Color fundus image. 45° FOV. 2184 by 1690 pixels:
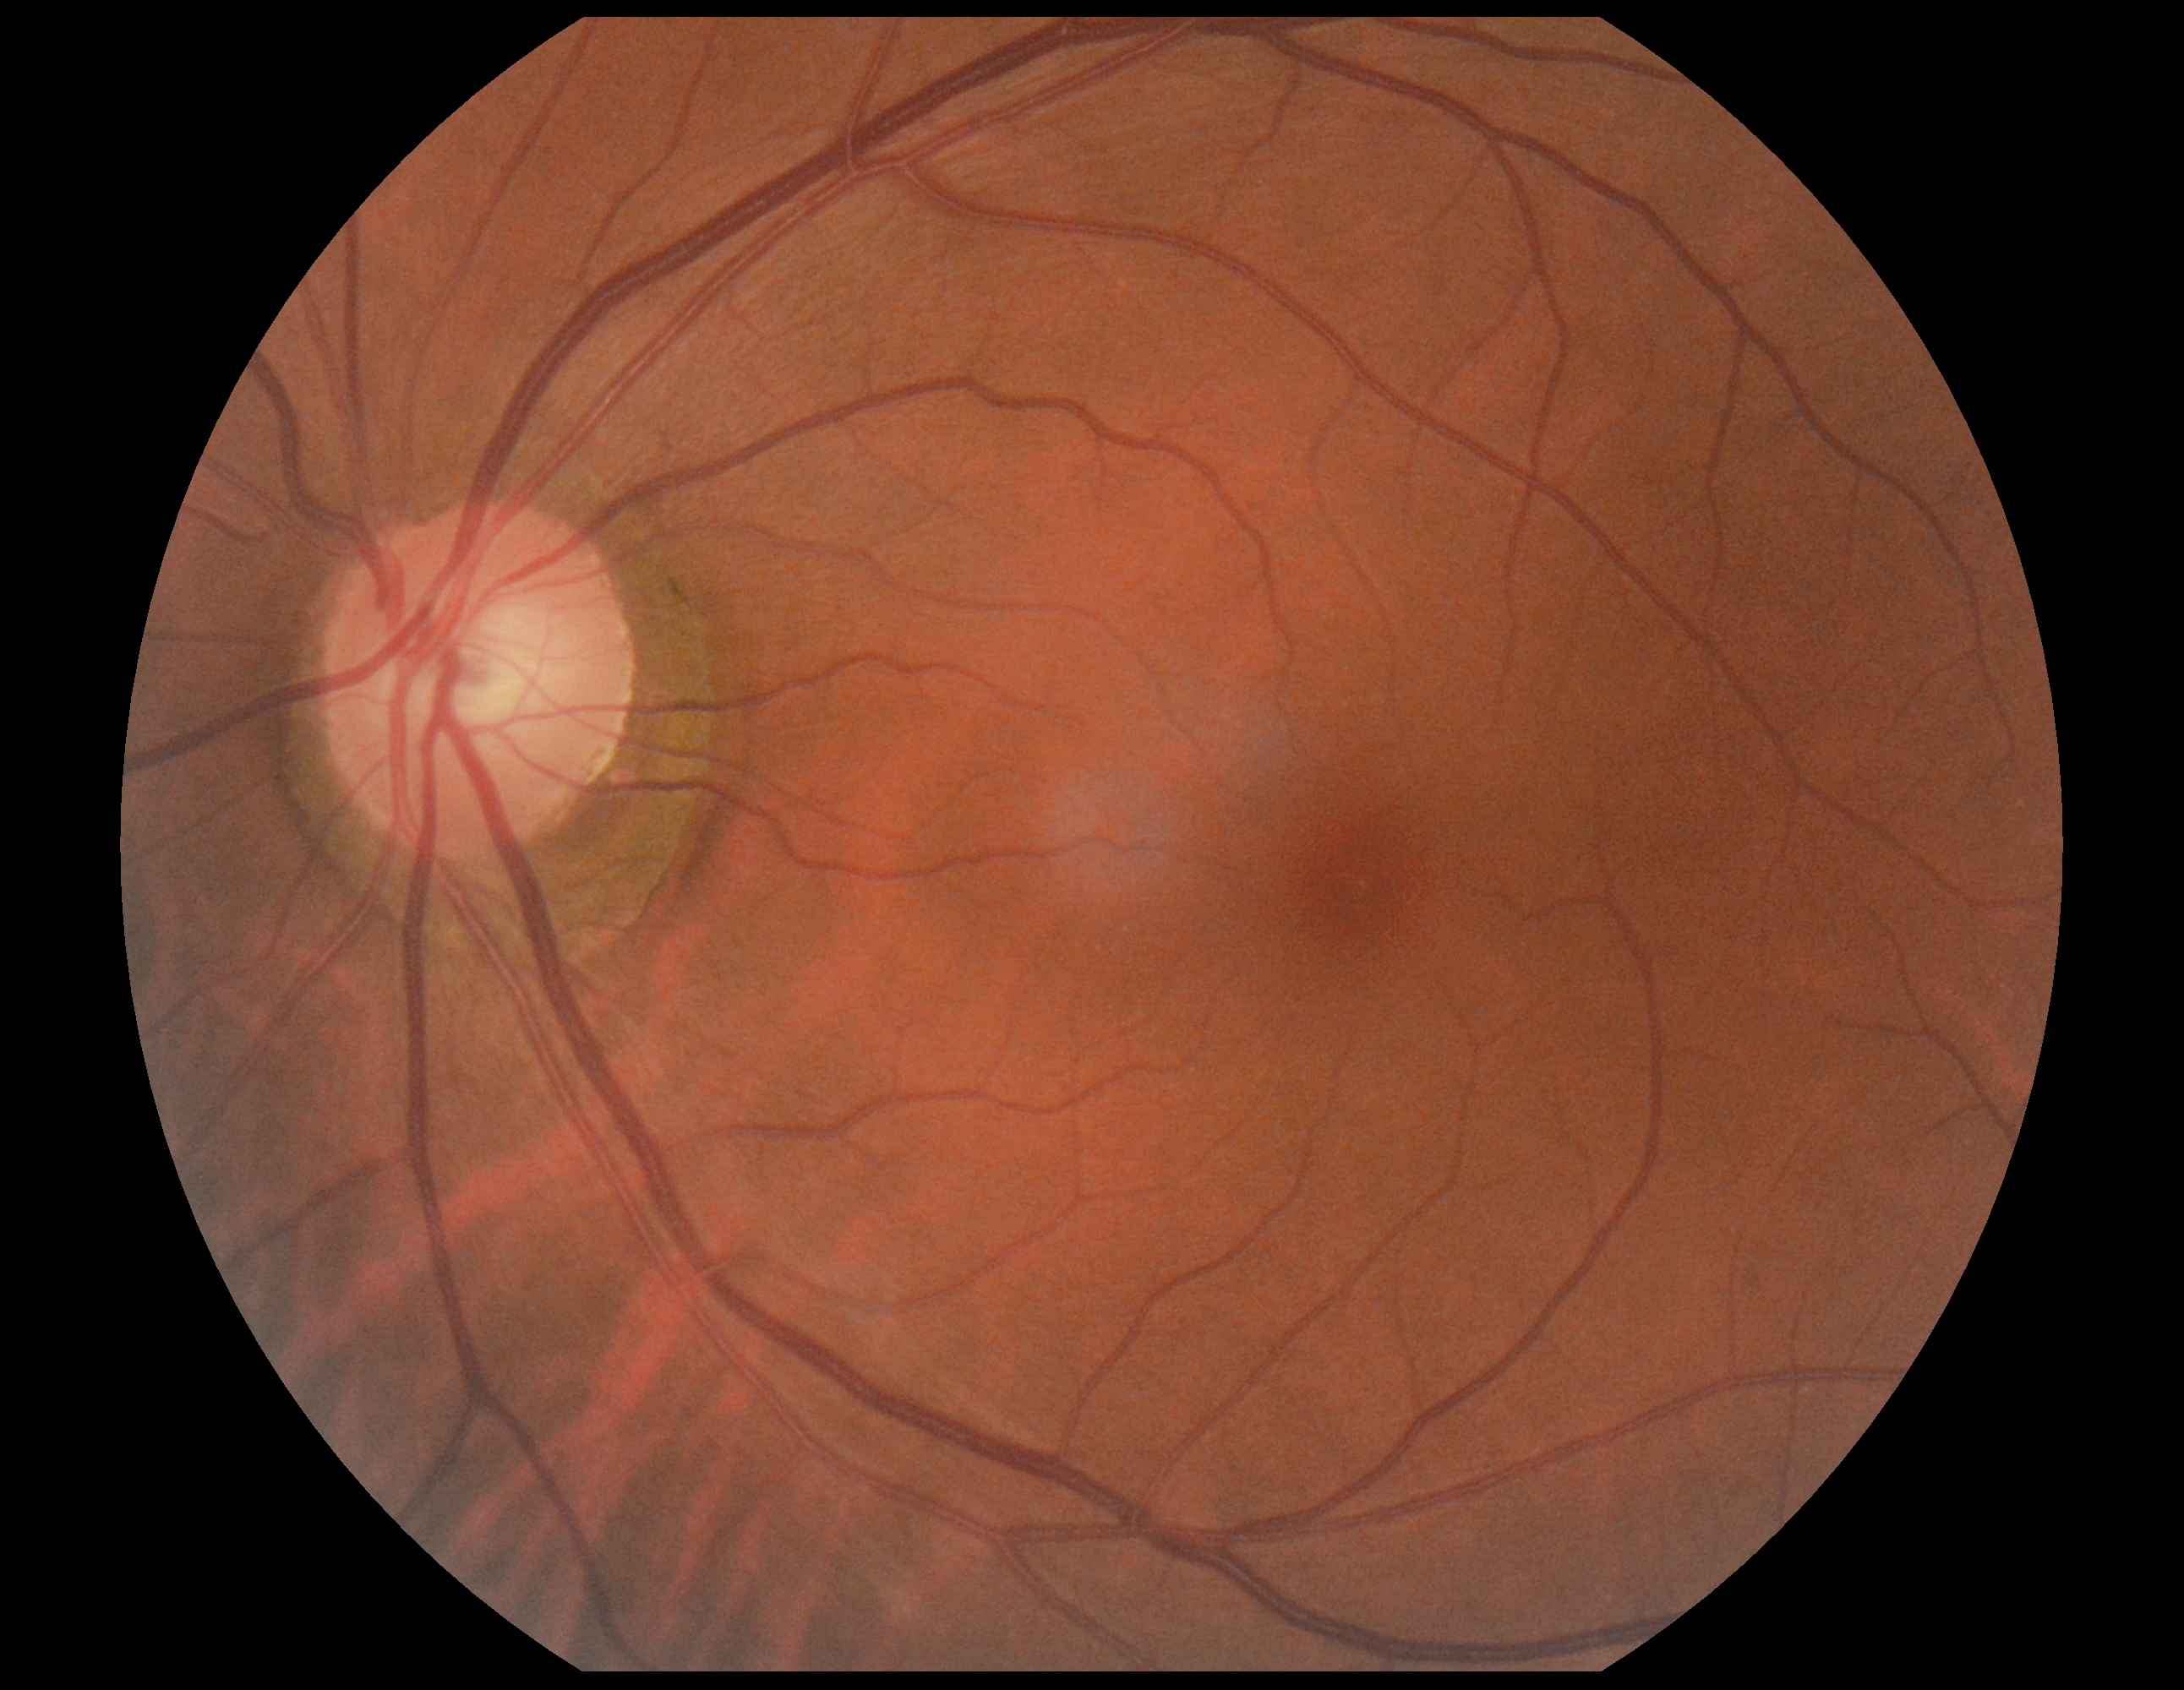   dr_impression: negative for DR
  dr_grade: 0